FOV: 45 degrees; no pharmacologic dilation; camera: NIDEK AFC-230.
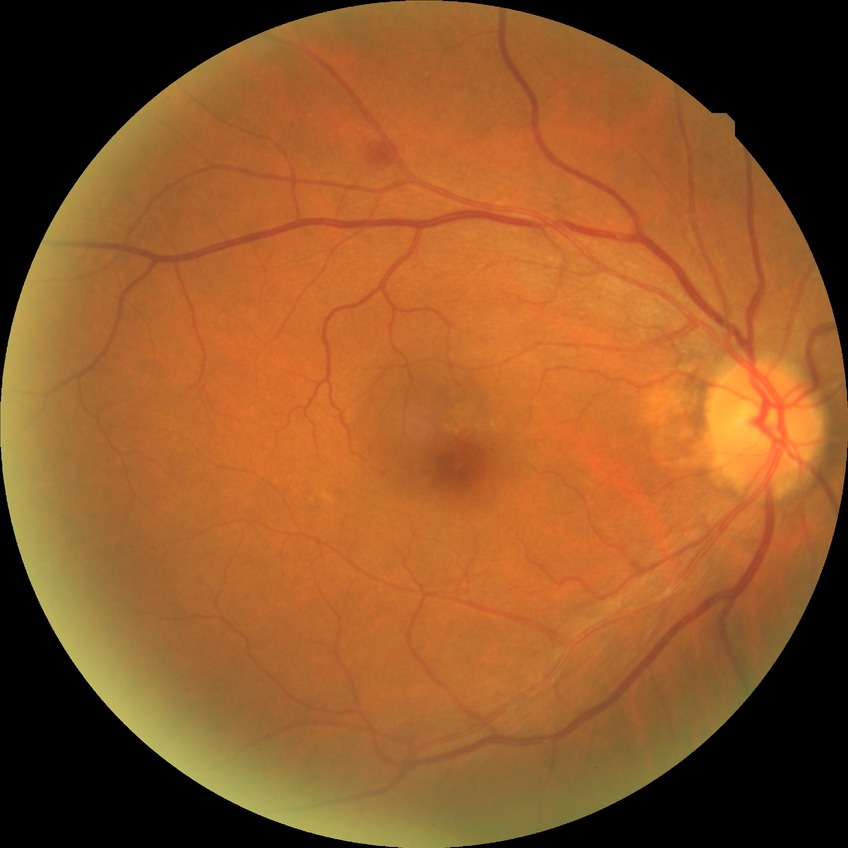
  davis_grade: no diabetic retinopathy (NDR)